Color fundus photograph, 2102 x 1736 pixels:
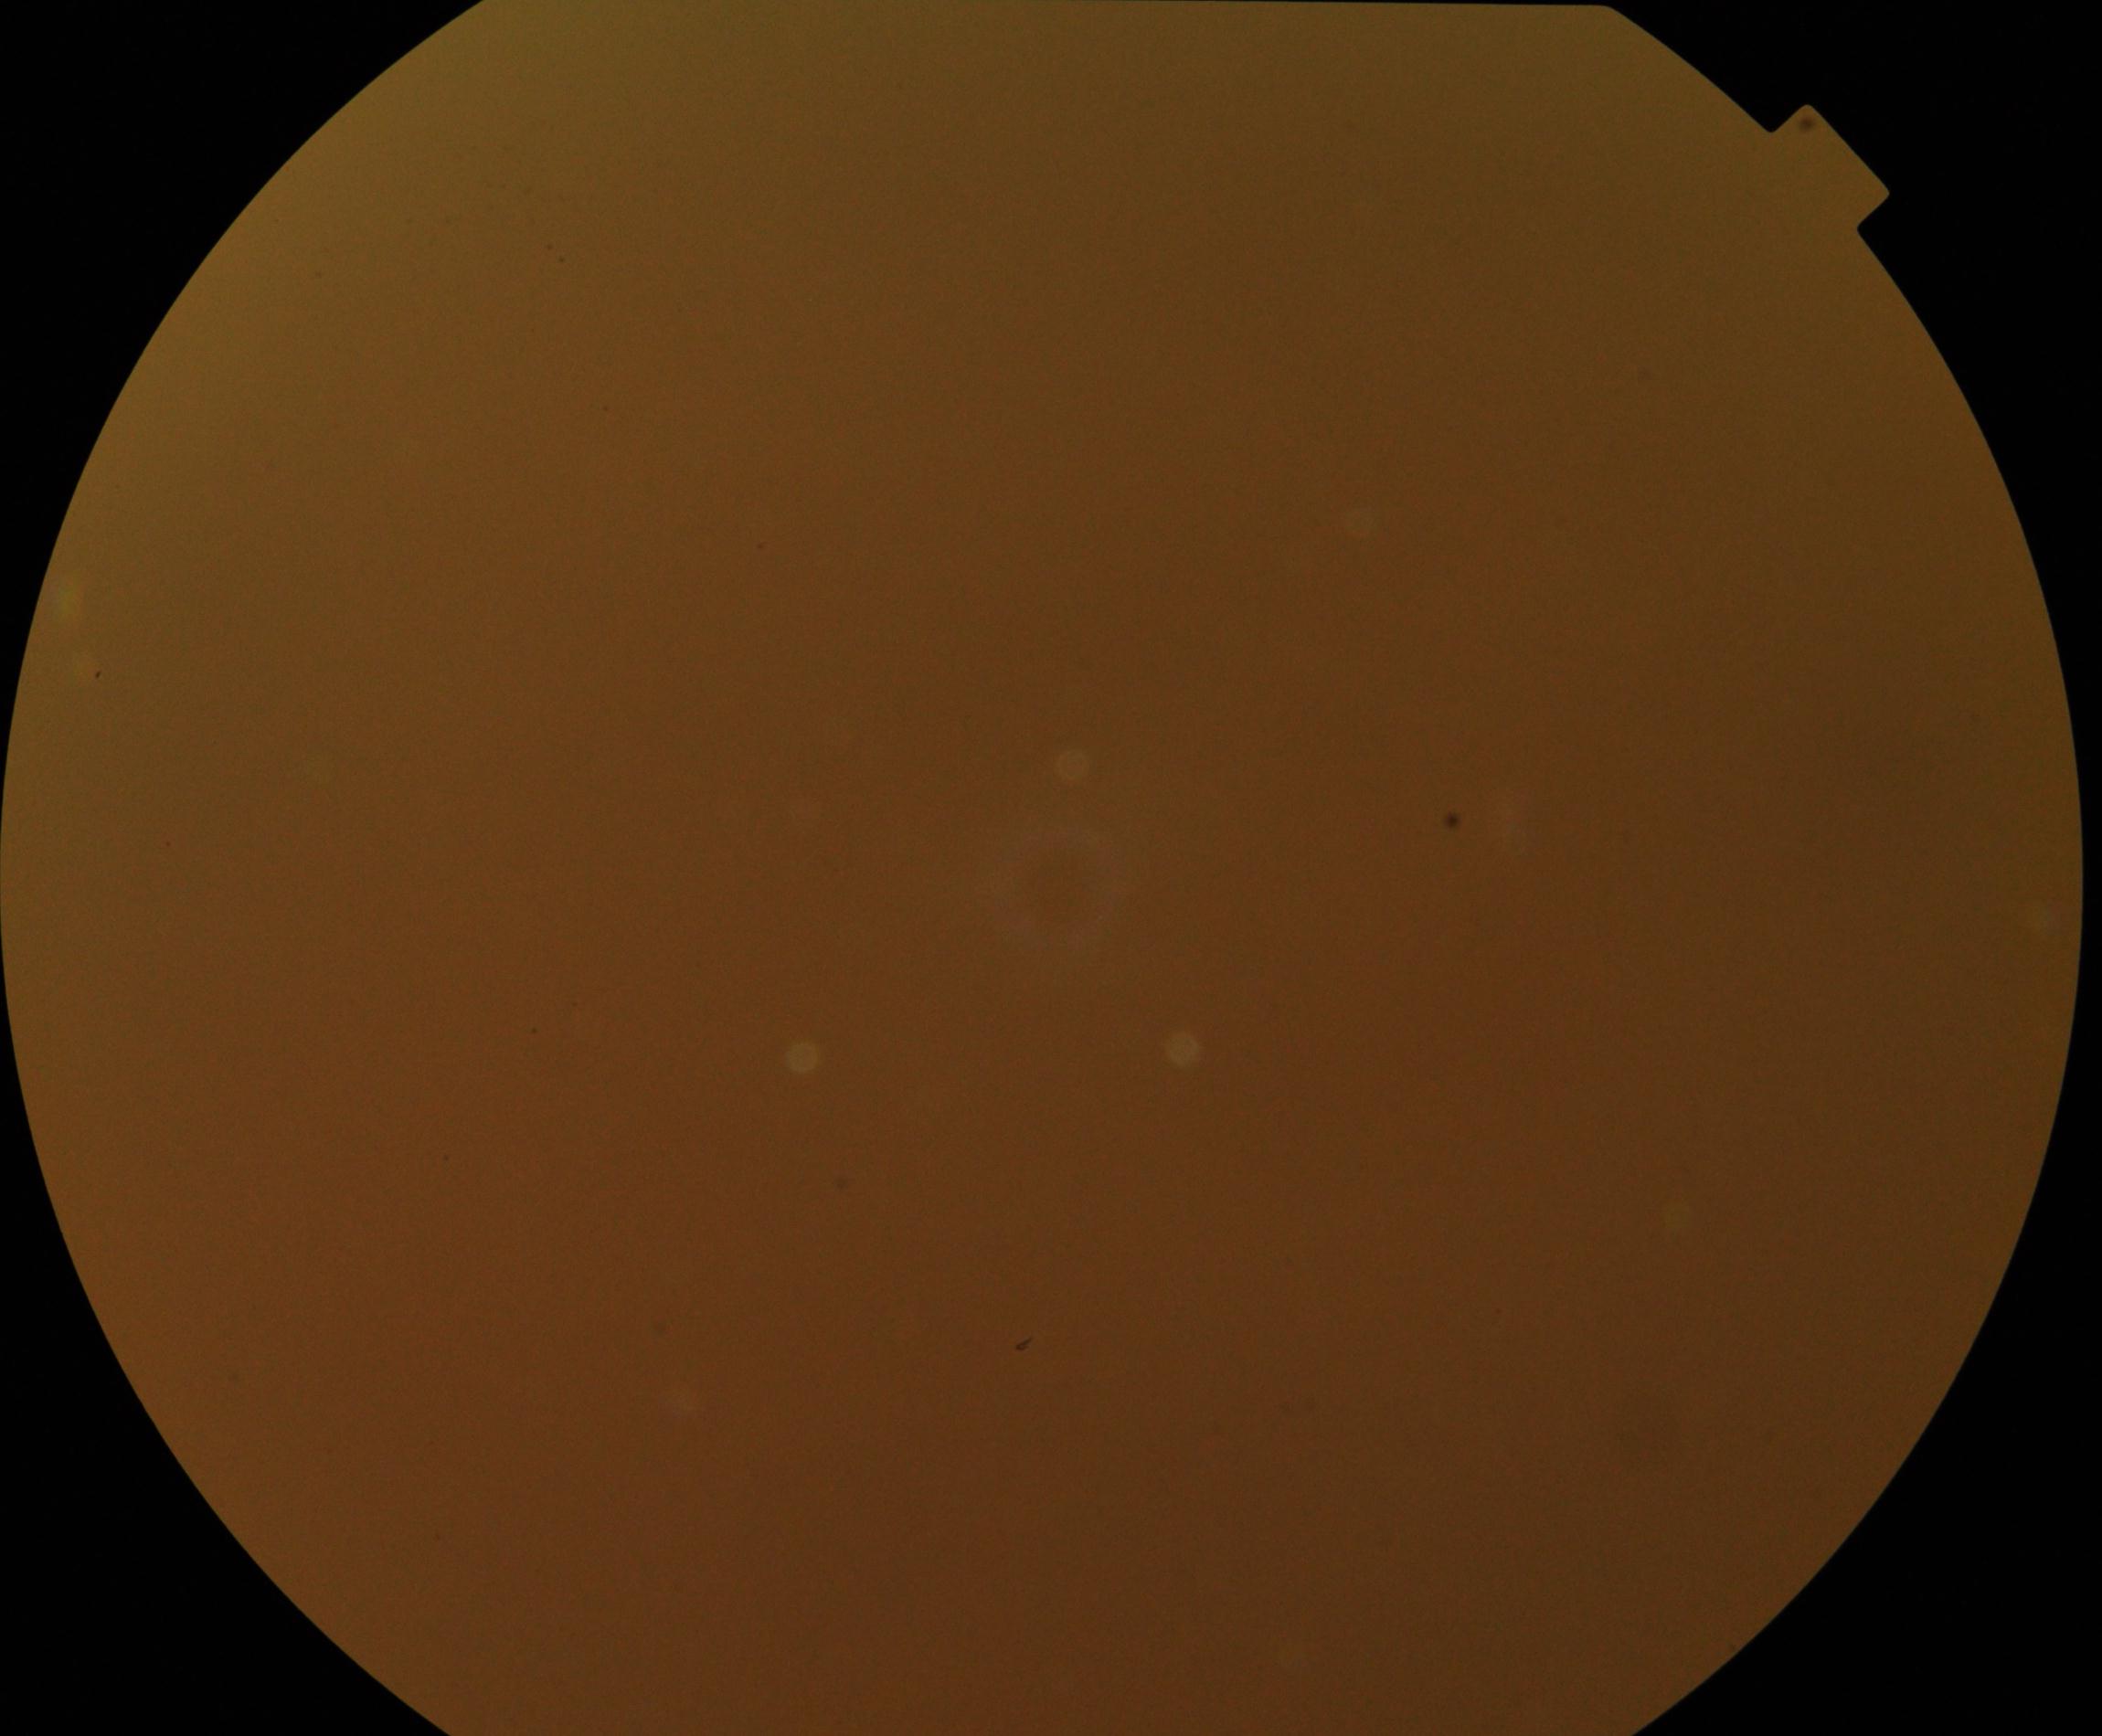 Image is blurred; retinal landmarks are largely obscured. Proliferative diabetic retinopathy not identified in the visible portion.